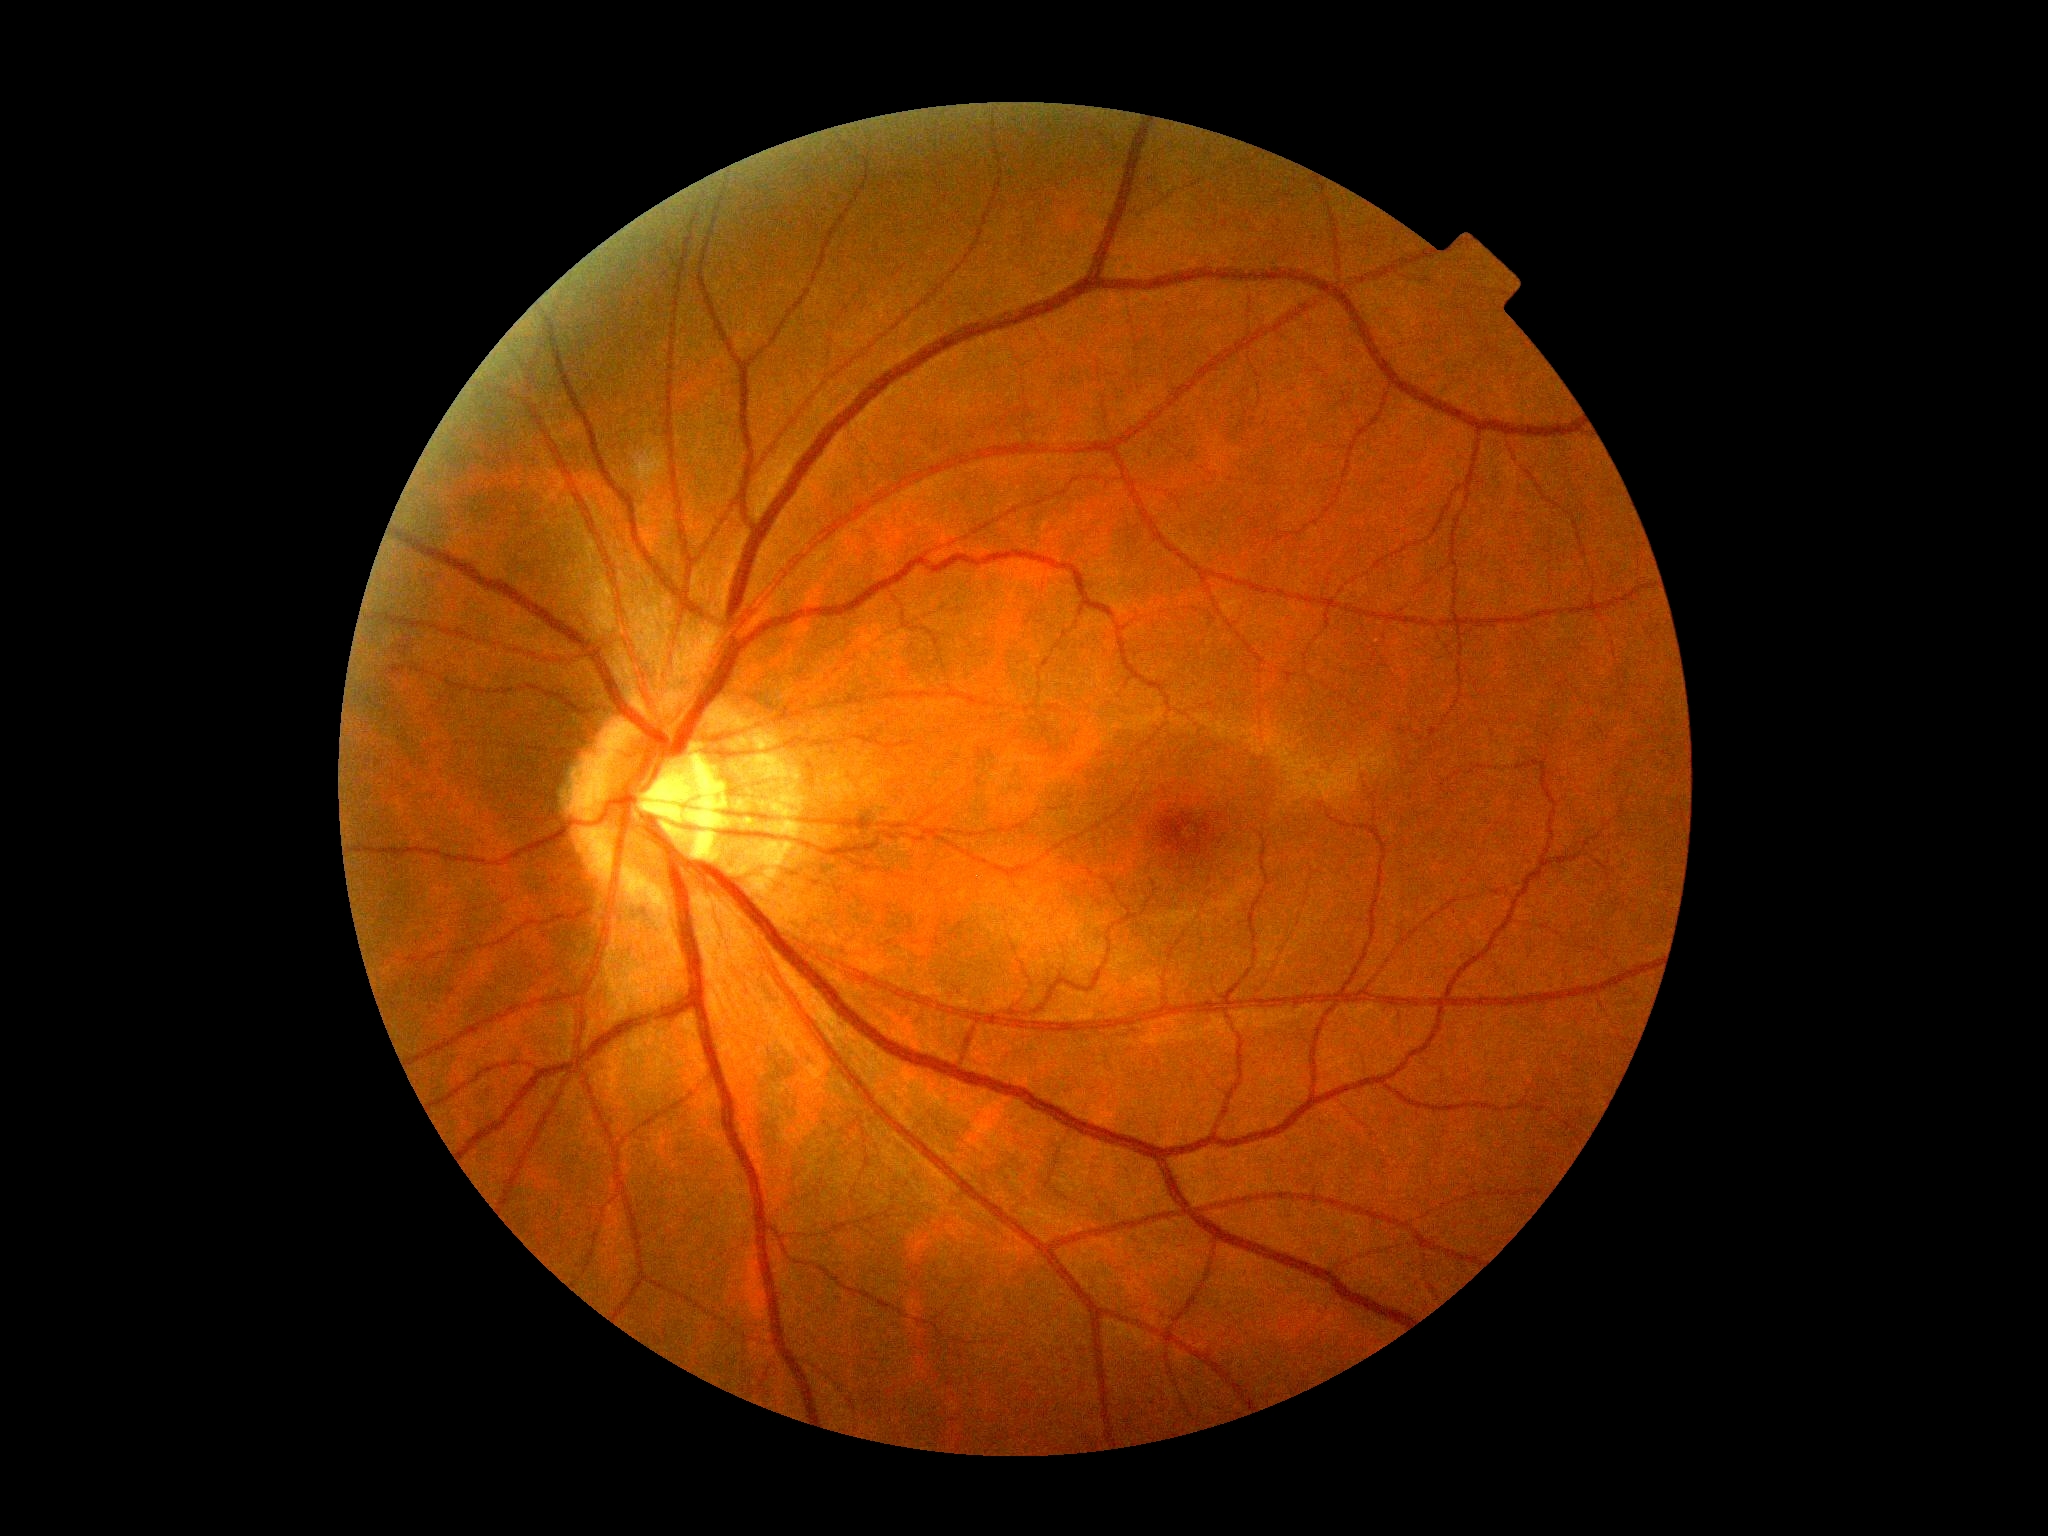
Diabetic retinopathy severity: 0/4.